Image size 1440x1080. Camera: Natus RetCam Envision (130° FOV). Pediatric wide-field fundus photograph.
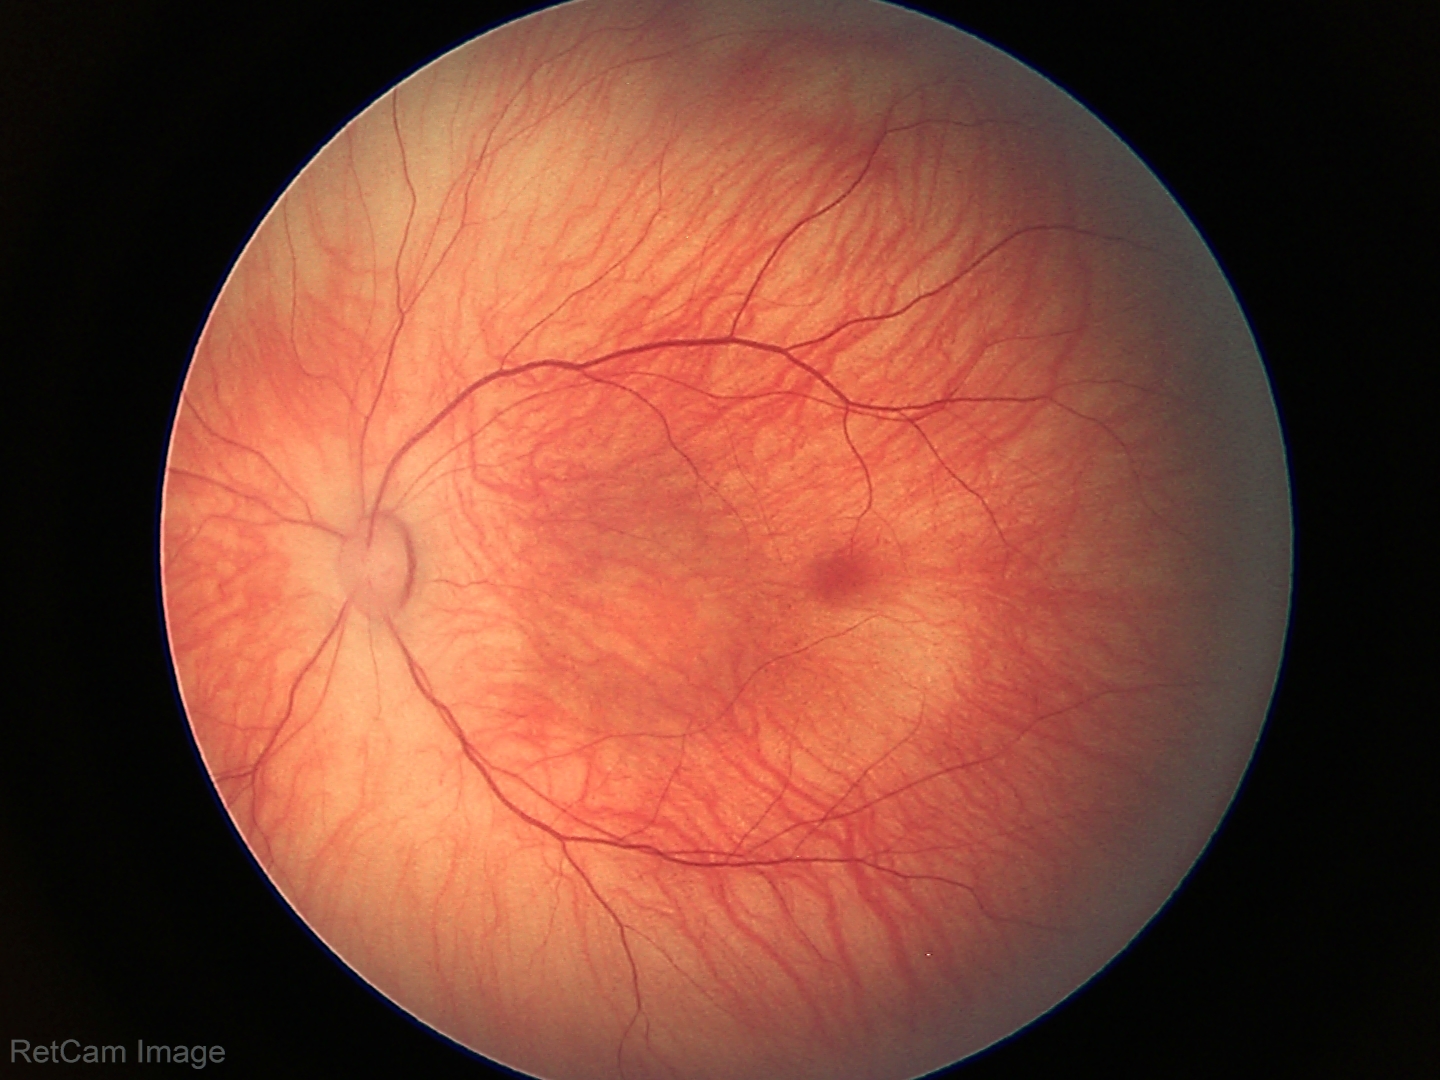

No retinal pathology identified on screening.